2346 by 1568 pixels
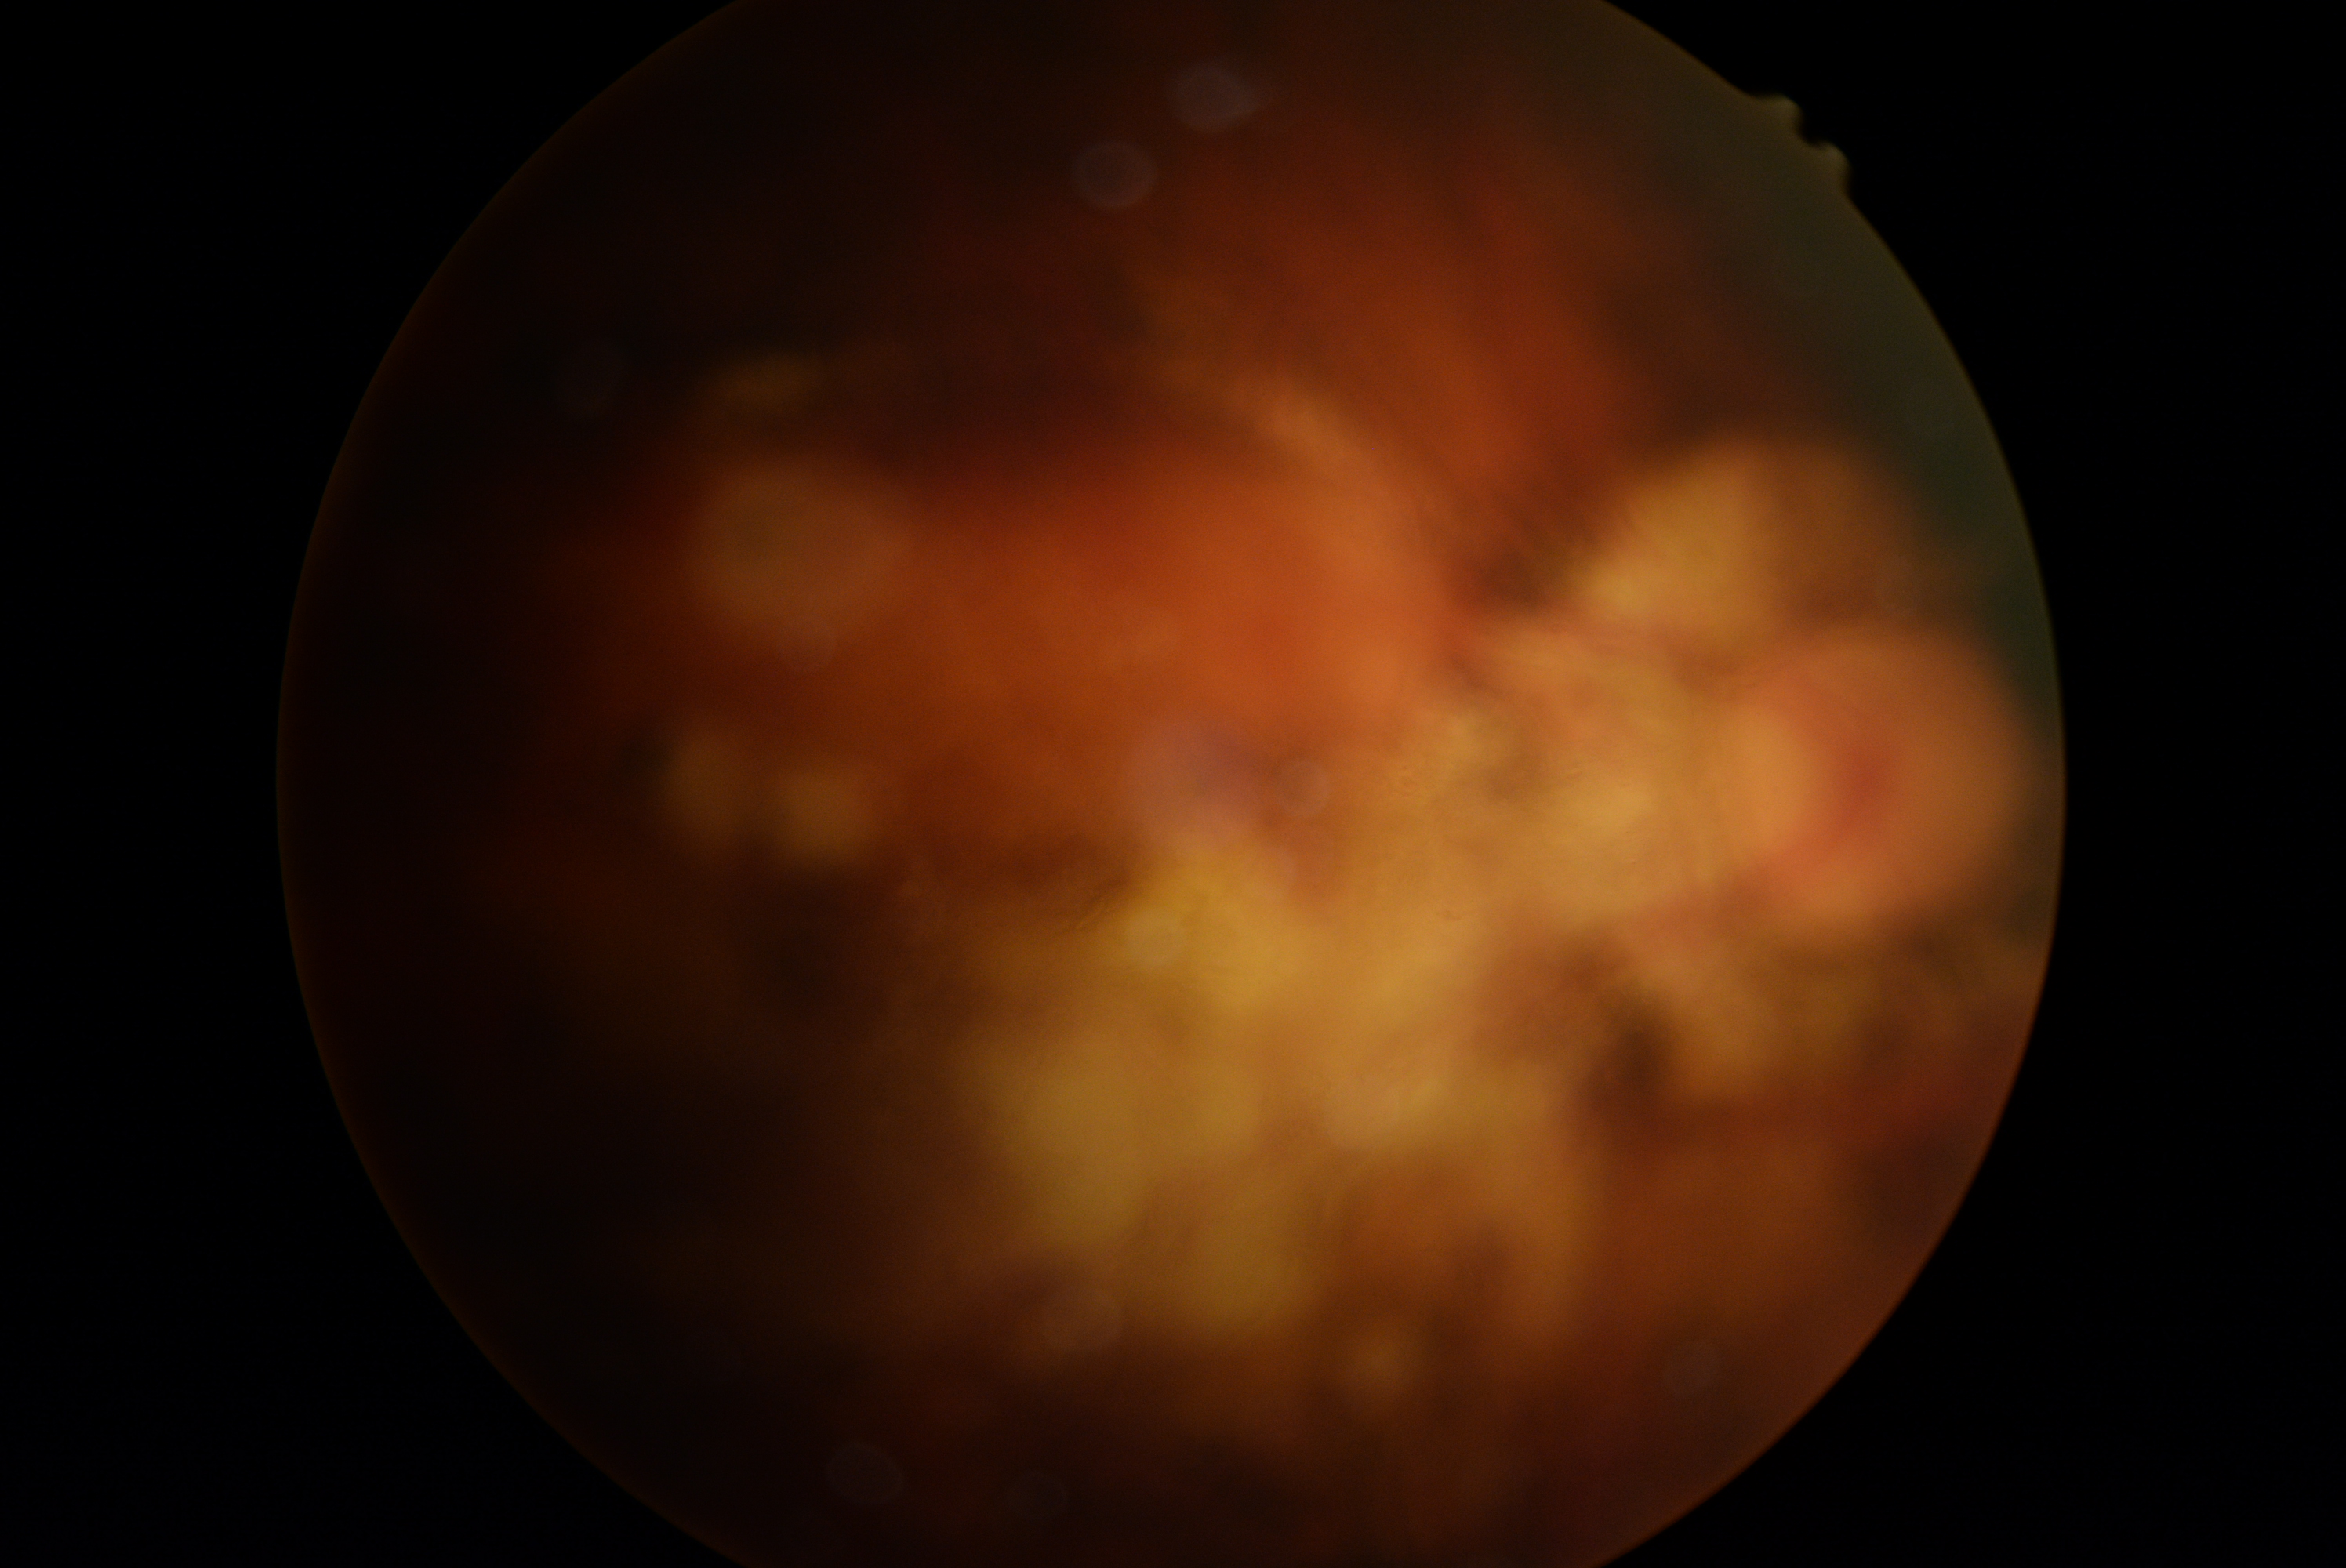
Diabetic retinopathy: ungradable due to poor image quality.